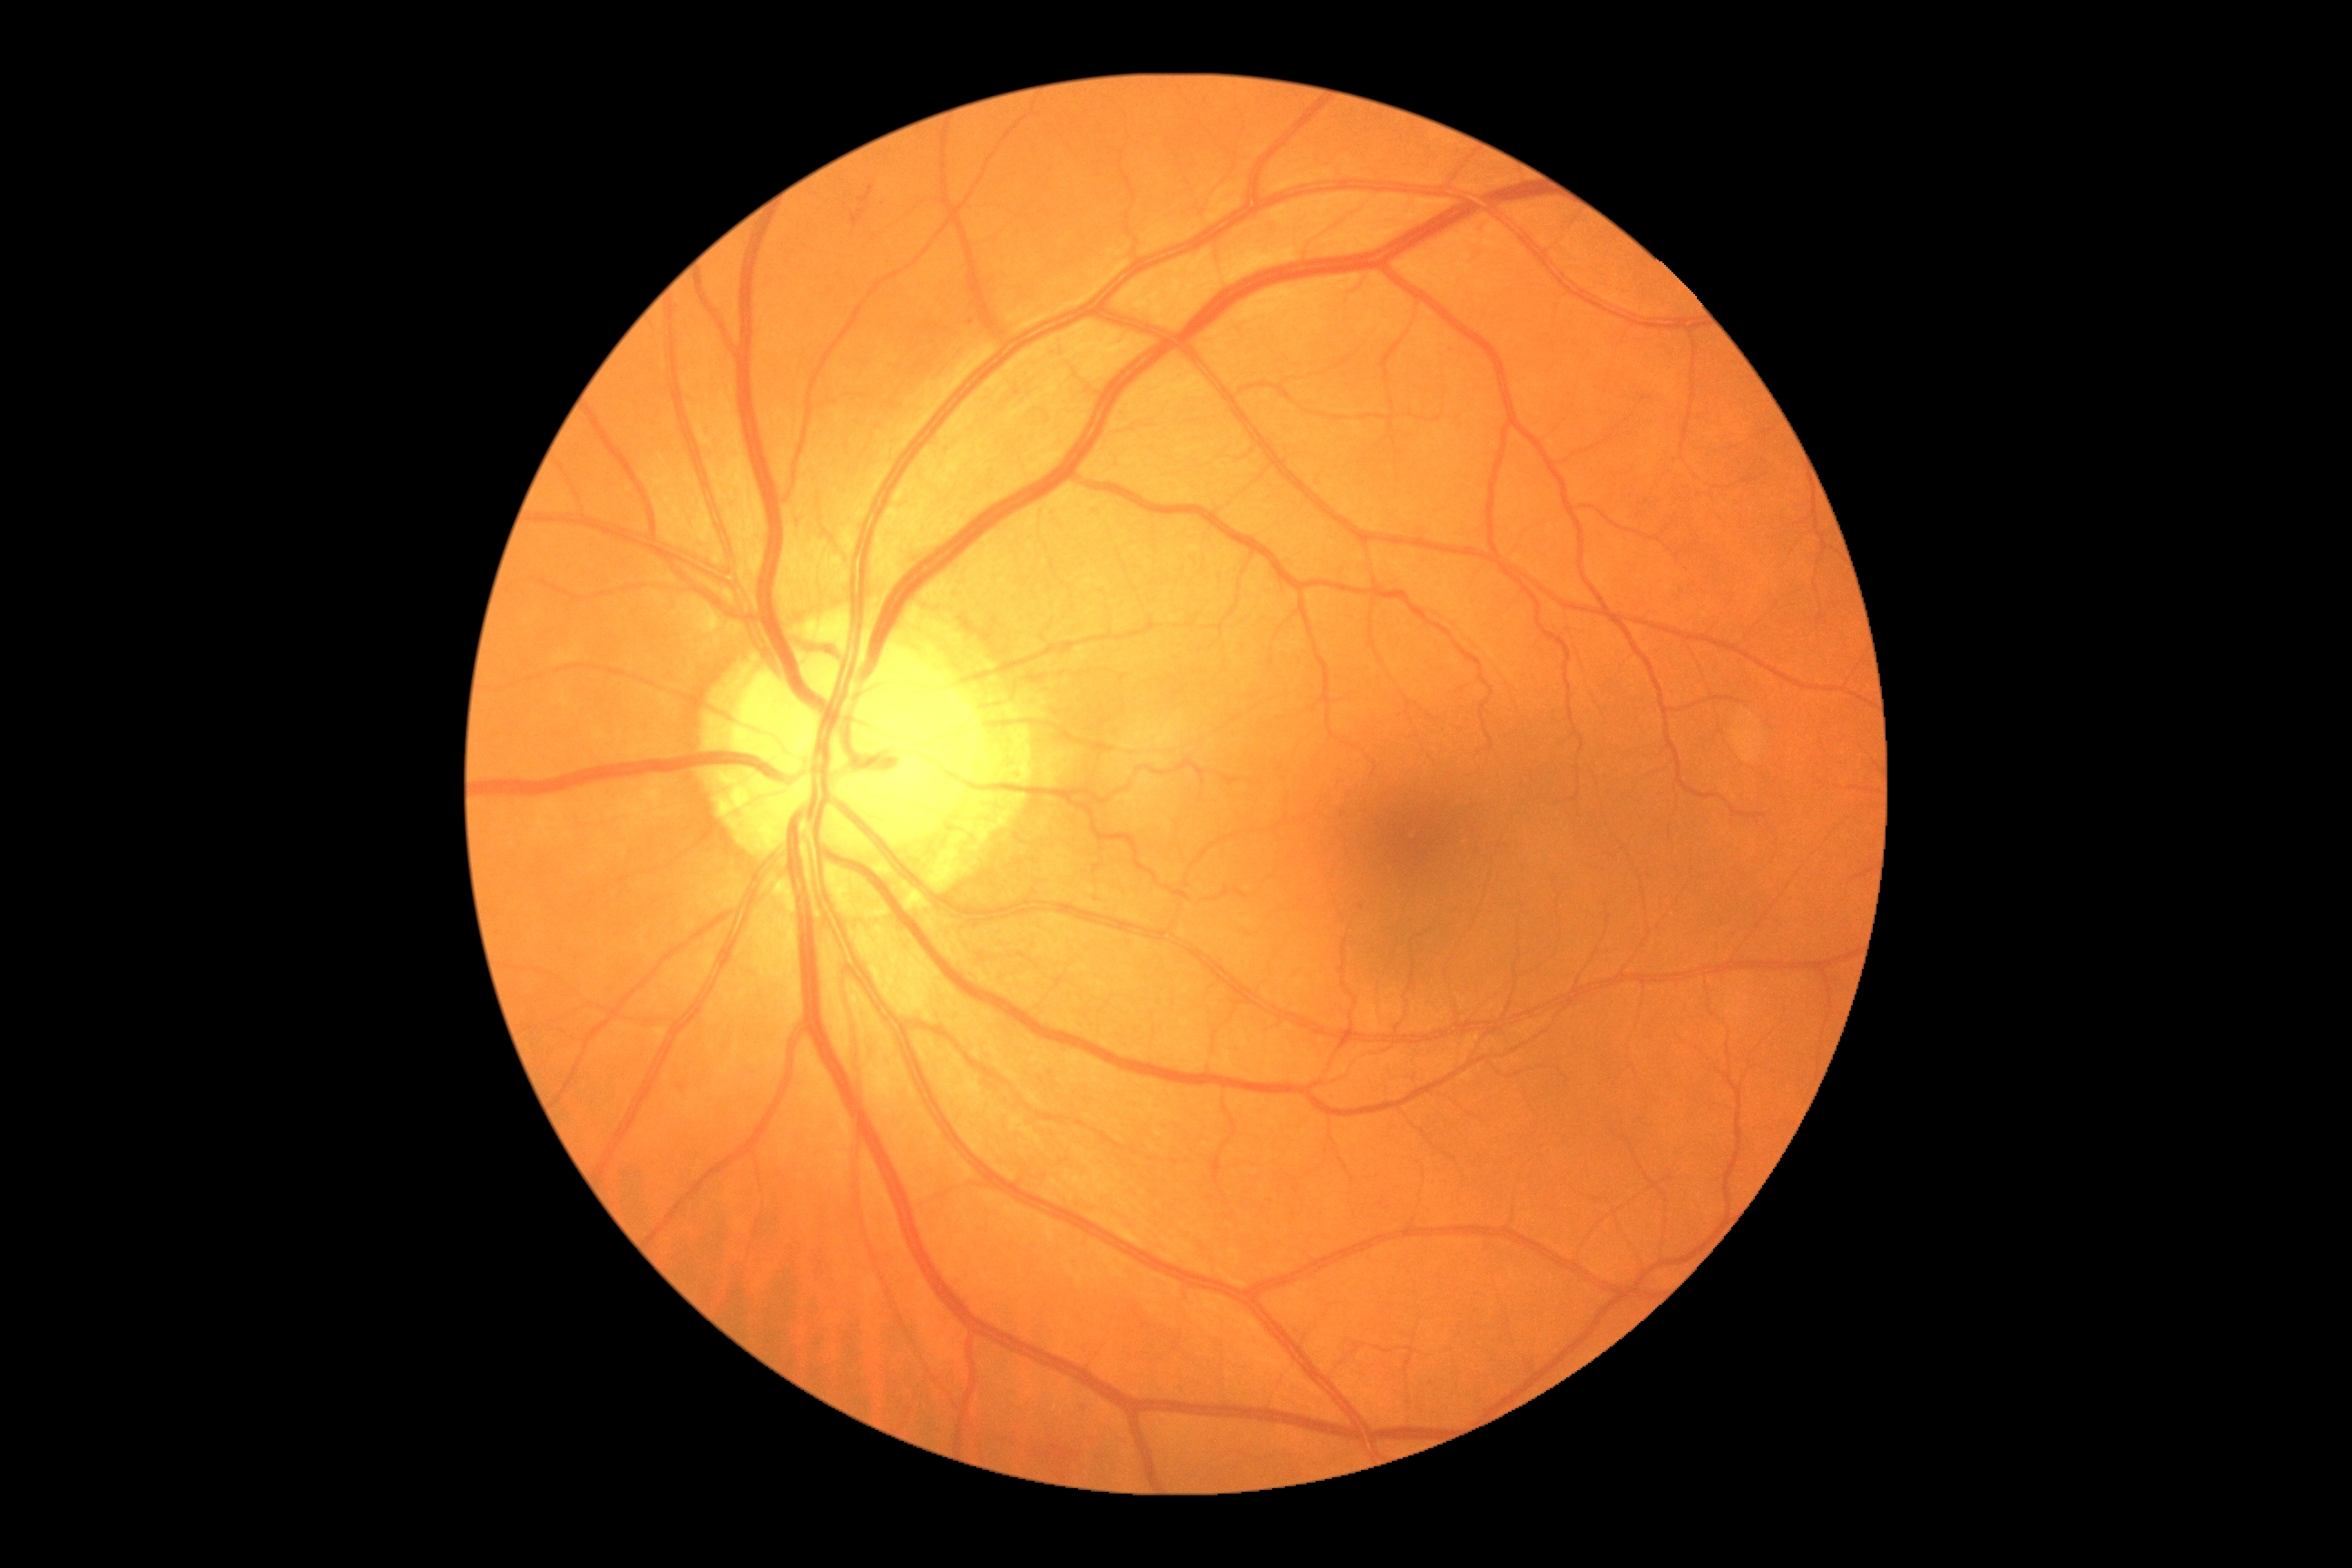 Diabetic retinopathy (DR): 2 — more than just microaneurysms but less than severe NPDR.